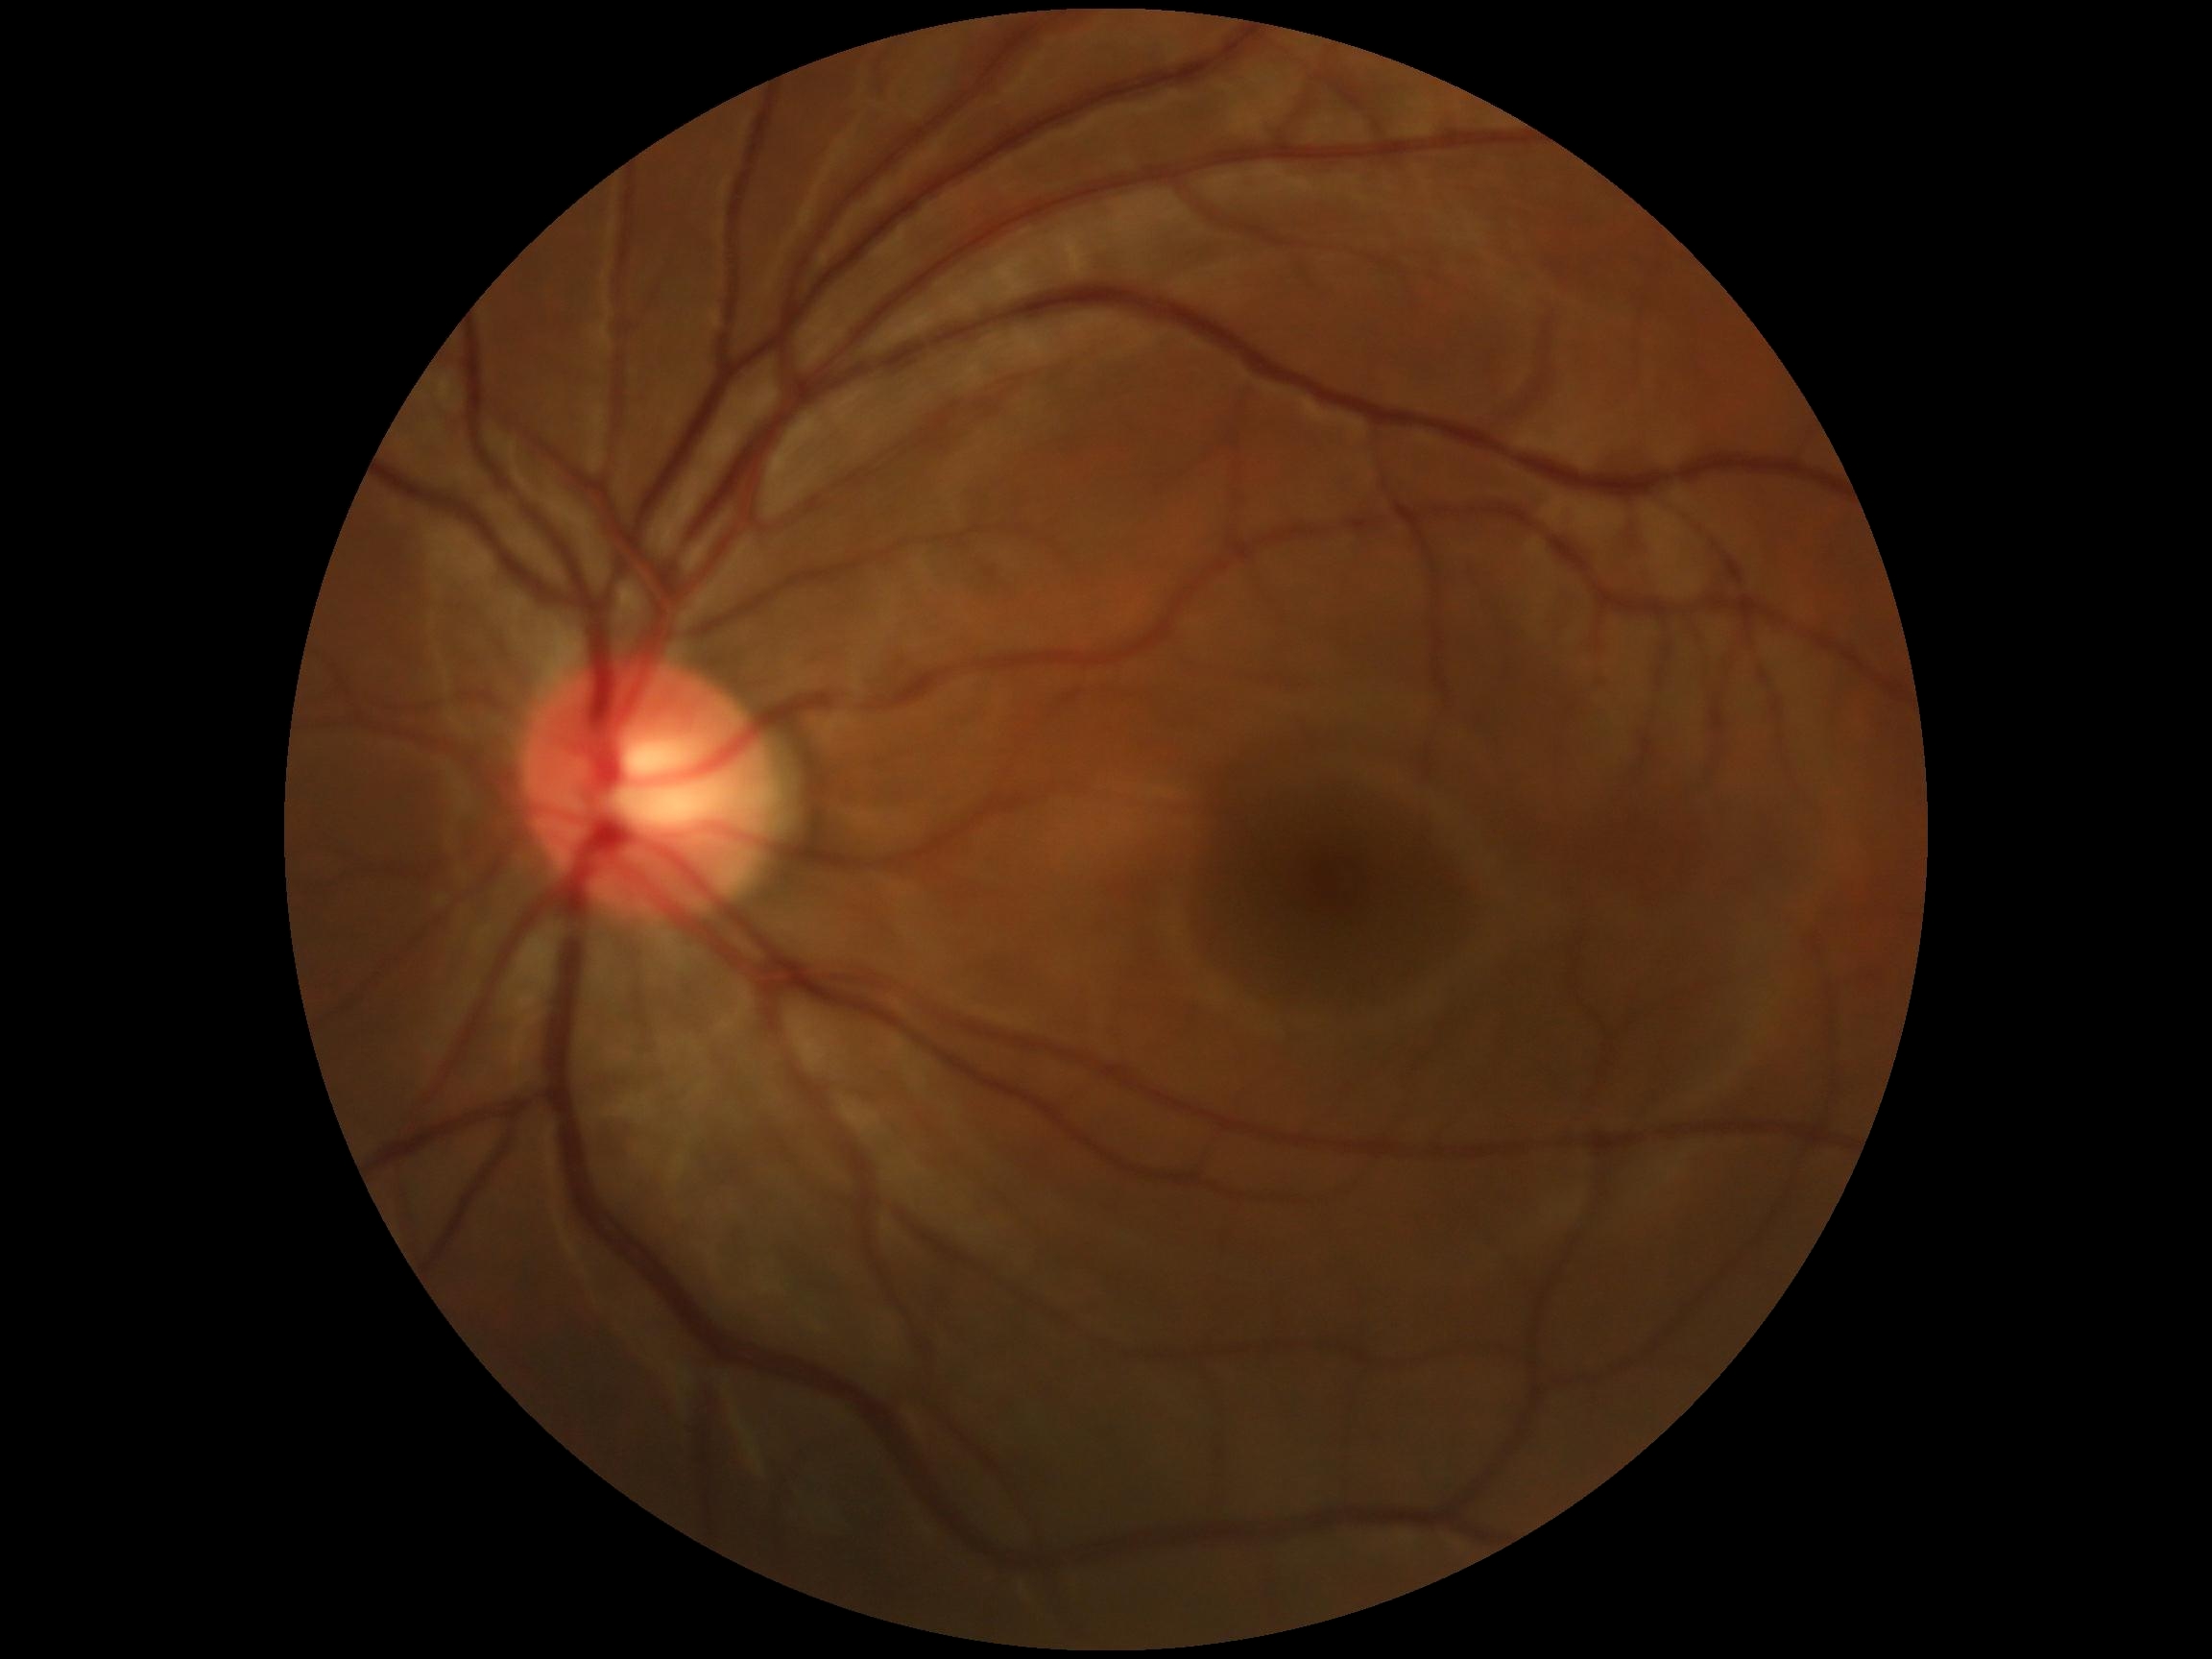
DR severity is grade 0 — no visible signs of diabetic retinopathy.